Retinal fundus photograph
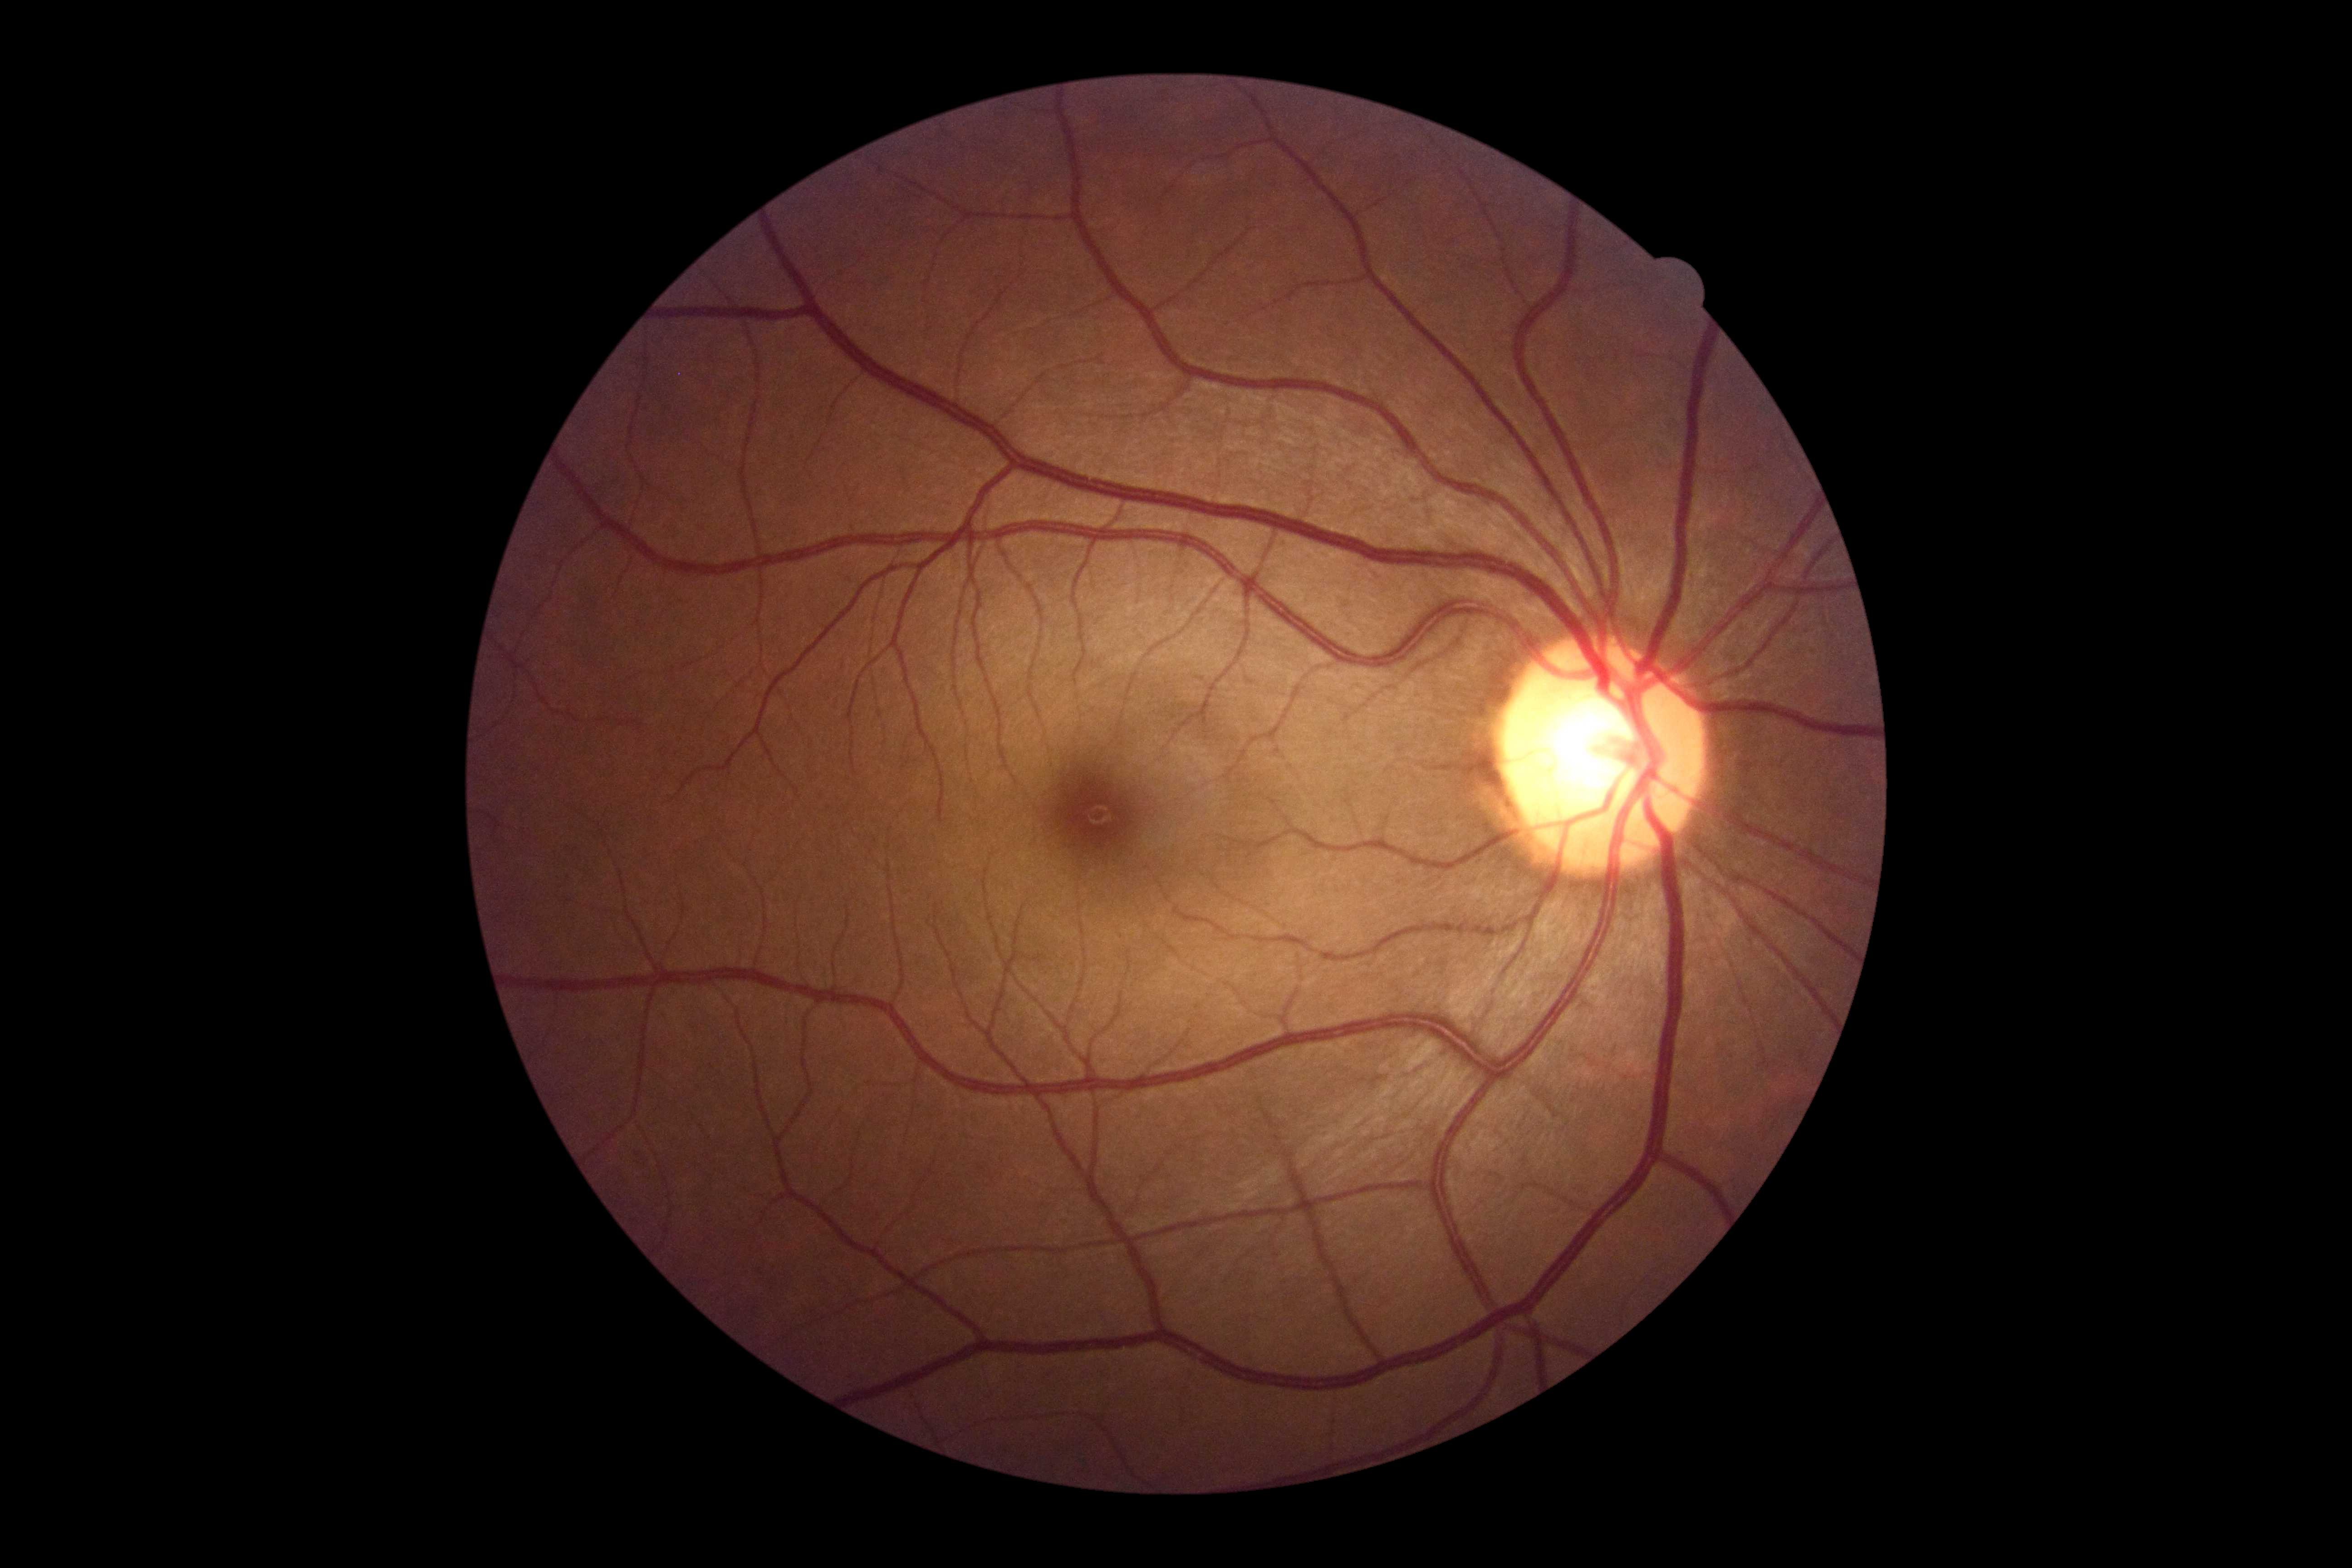
Findings:
• retinopathy — grade 0 (no apparent retinopathy)
• DR impression — no apparent DR